45° field of view; nonmydriatic; modified Davis grading; CFP:
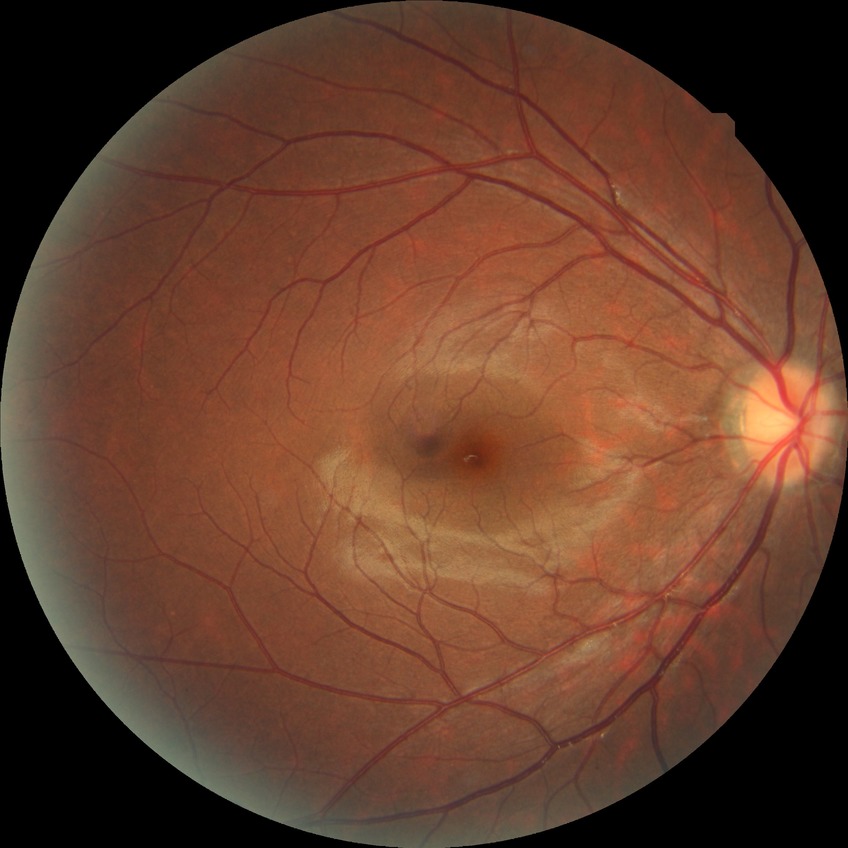
{"davis_grade": "NDR"}